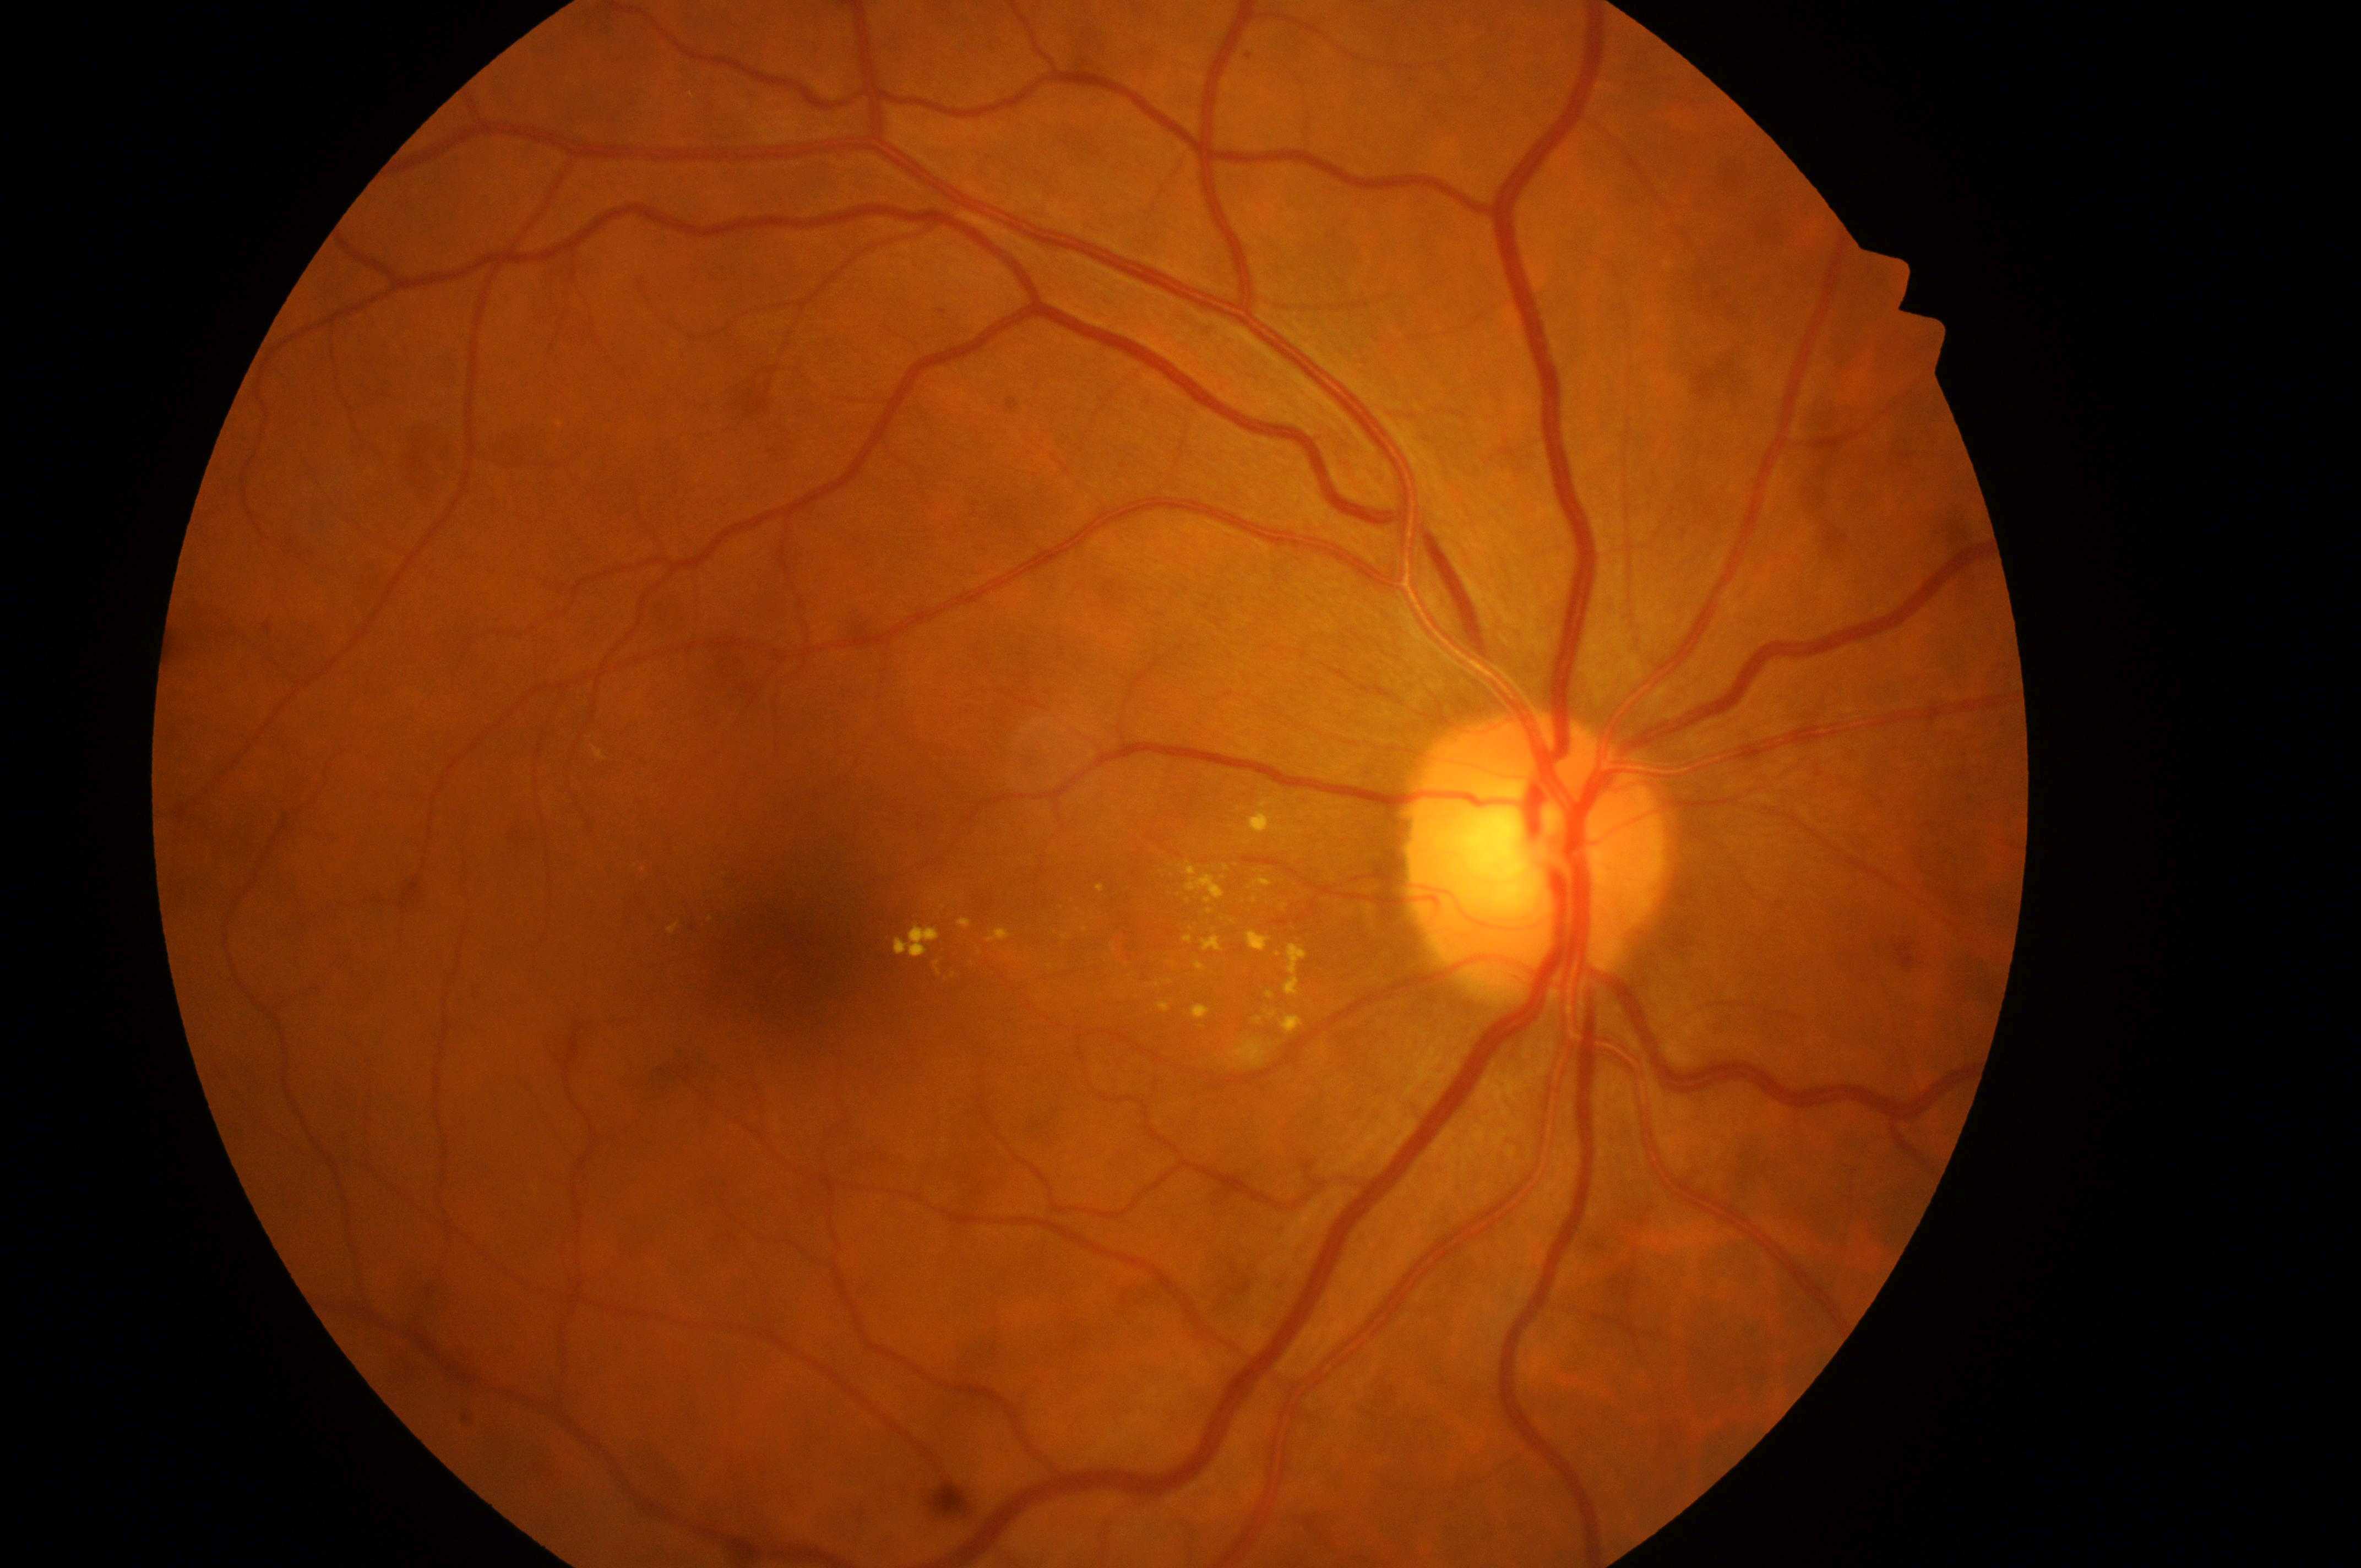
diabetic macular edema (DME)@grade 2 (high risk) — hard exudates within one disc diameter of the macula center | fovea@(786,959) | diabetic retinopathy (DR)@moderate NPDR (grade 2) — more than just microaneurysms but less than severe NPDR | disc center@(1531,862) | oculus dexter.